Color fundus image; 848 x 848 pixels; 45 degree fundus photograph; nonmydriatic fundus photograph — 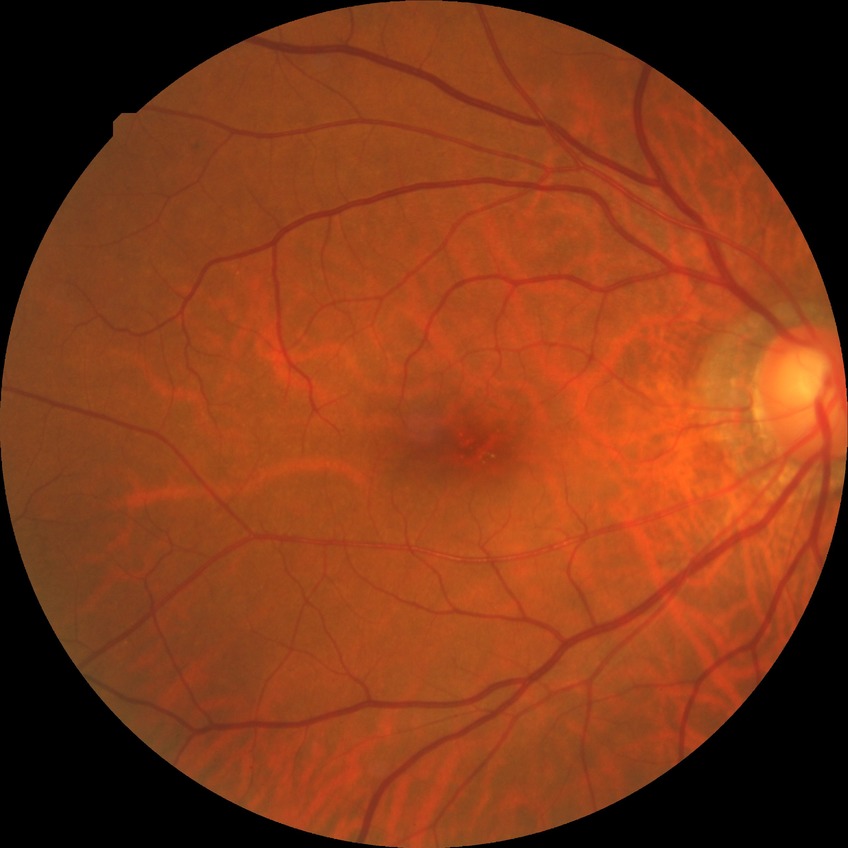
Findings:
– diabetic retinopathy (DR) — NDR (no diabetic retinopathy)